2212x1659 — 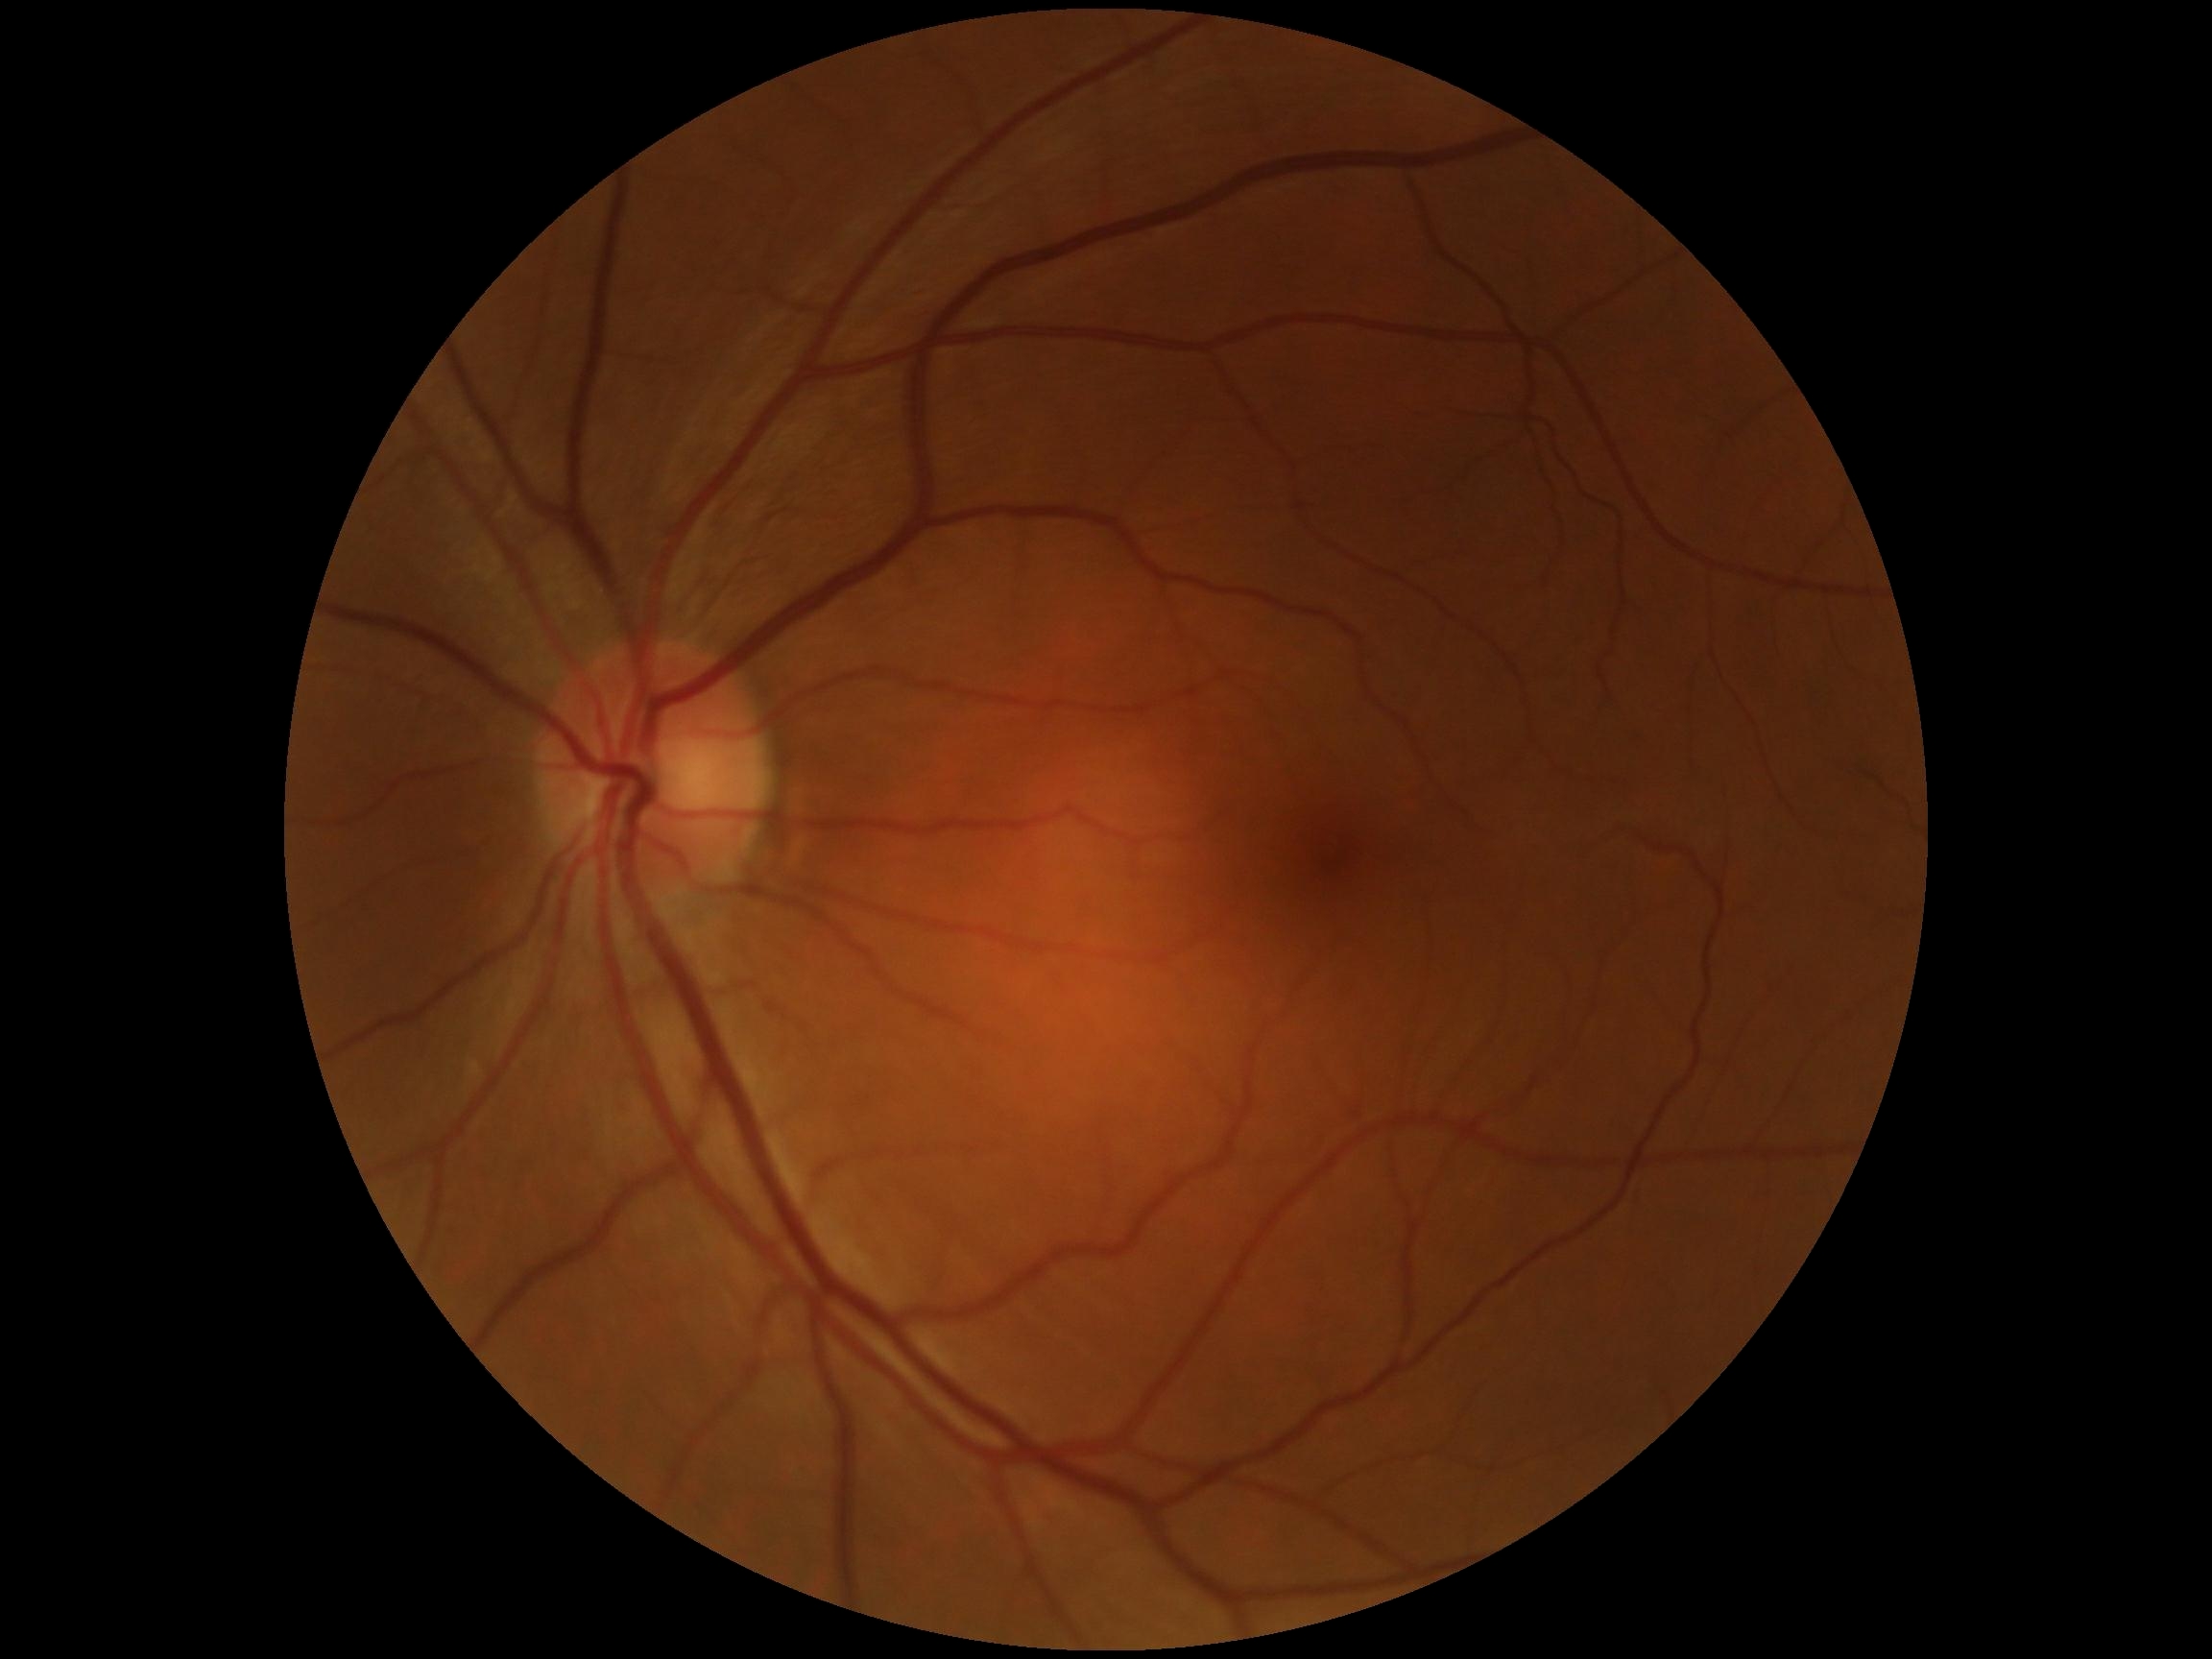

Diabetic retinopathy severity: 0.
No diabetic retinal disease findings.